Without pupil dilation. Camera: NIDEK AFC-230. 848x848px — 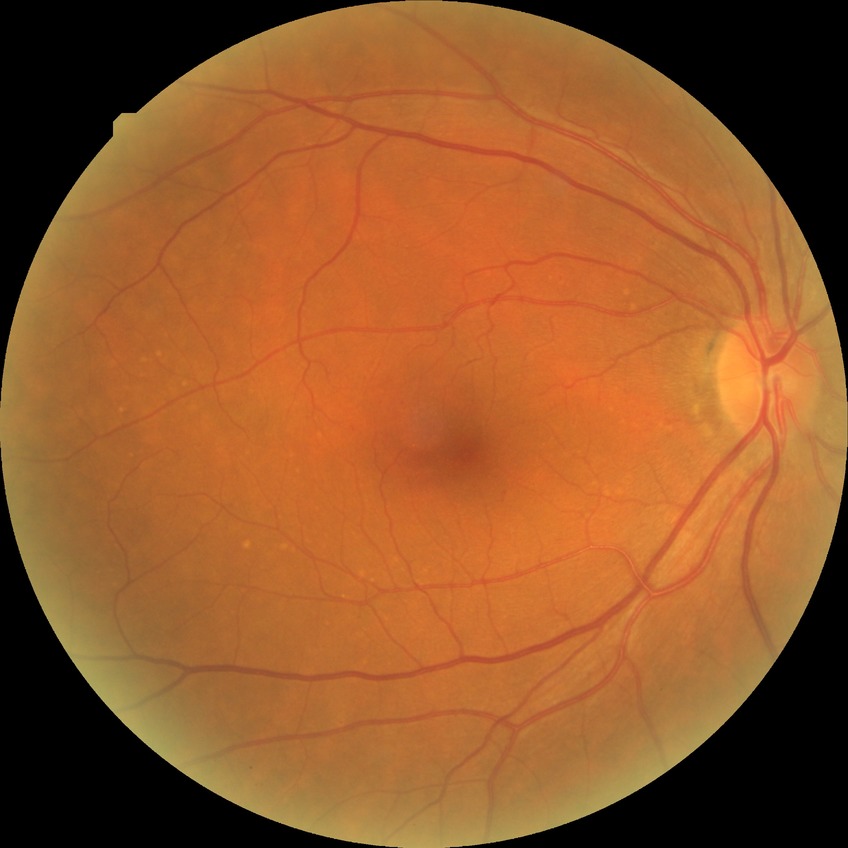

davis_grade: NDR
dr_impression: no signs of DR